Pediatric wide-field fundus photograph — 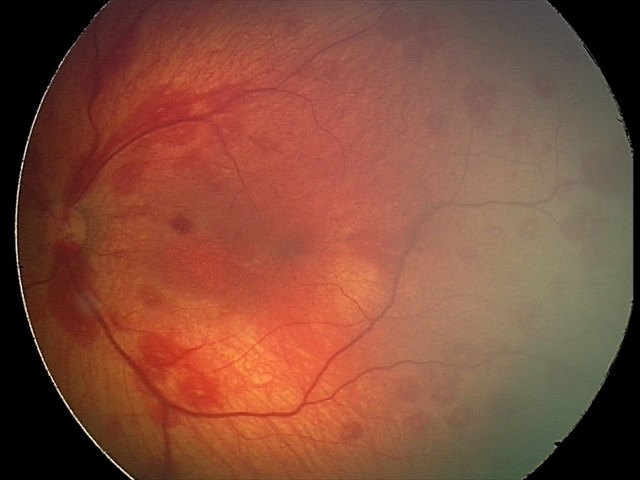
Q: What was the screening finding?
A: retinal hemorrhages